Color fundus image · image size 2352x1568 · 45-degree field of view
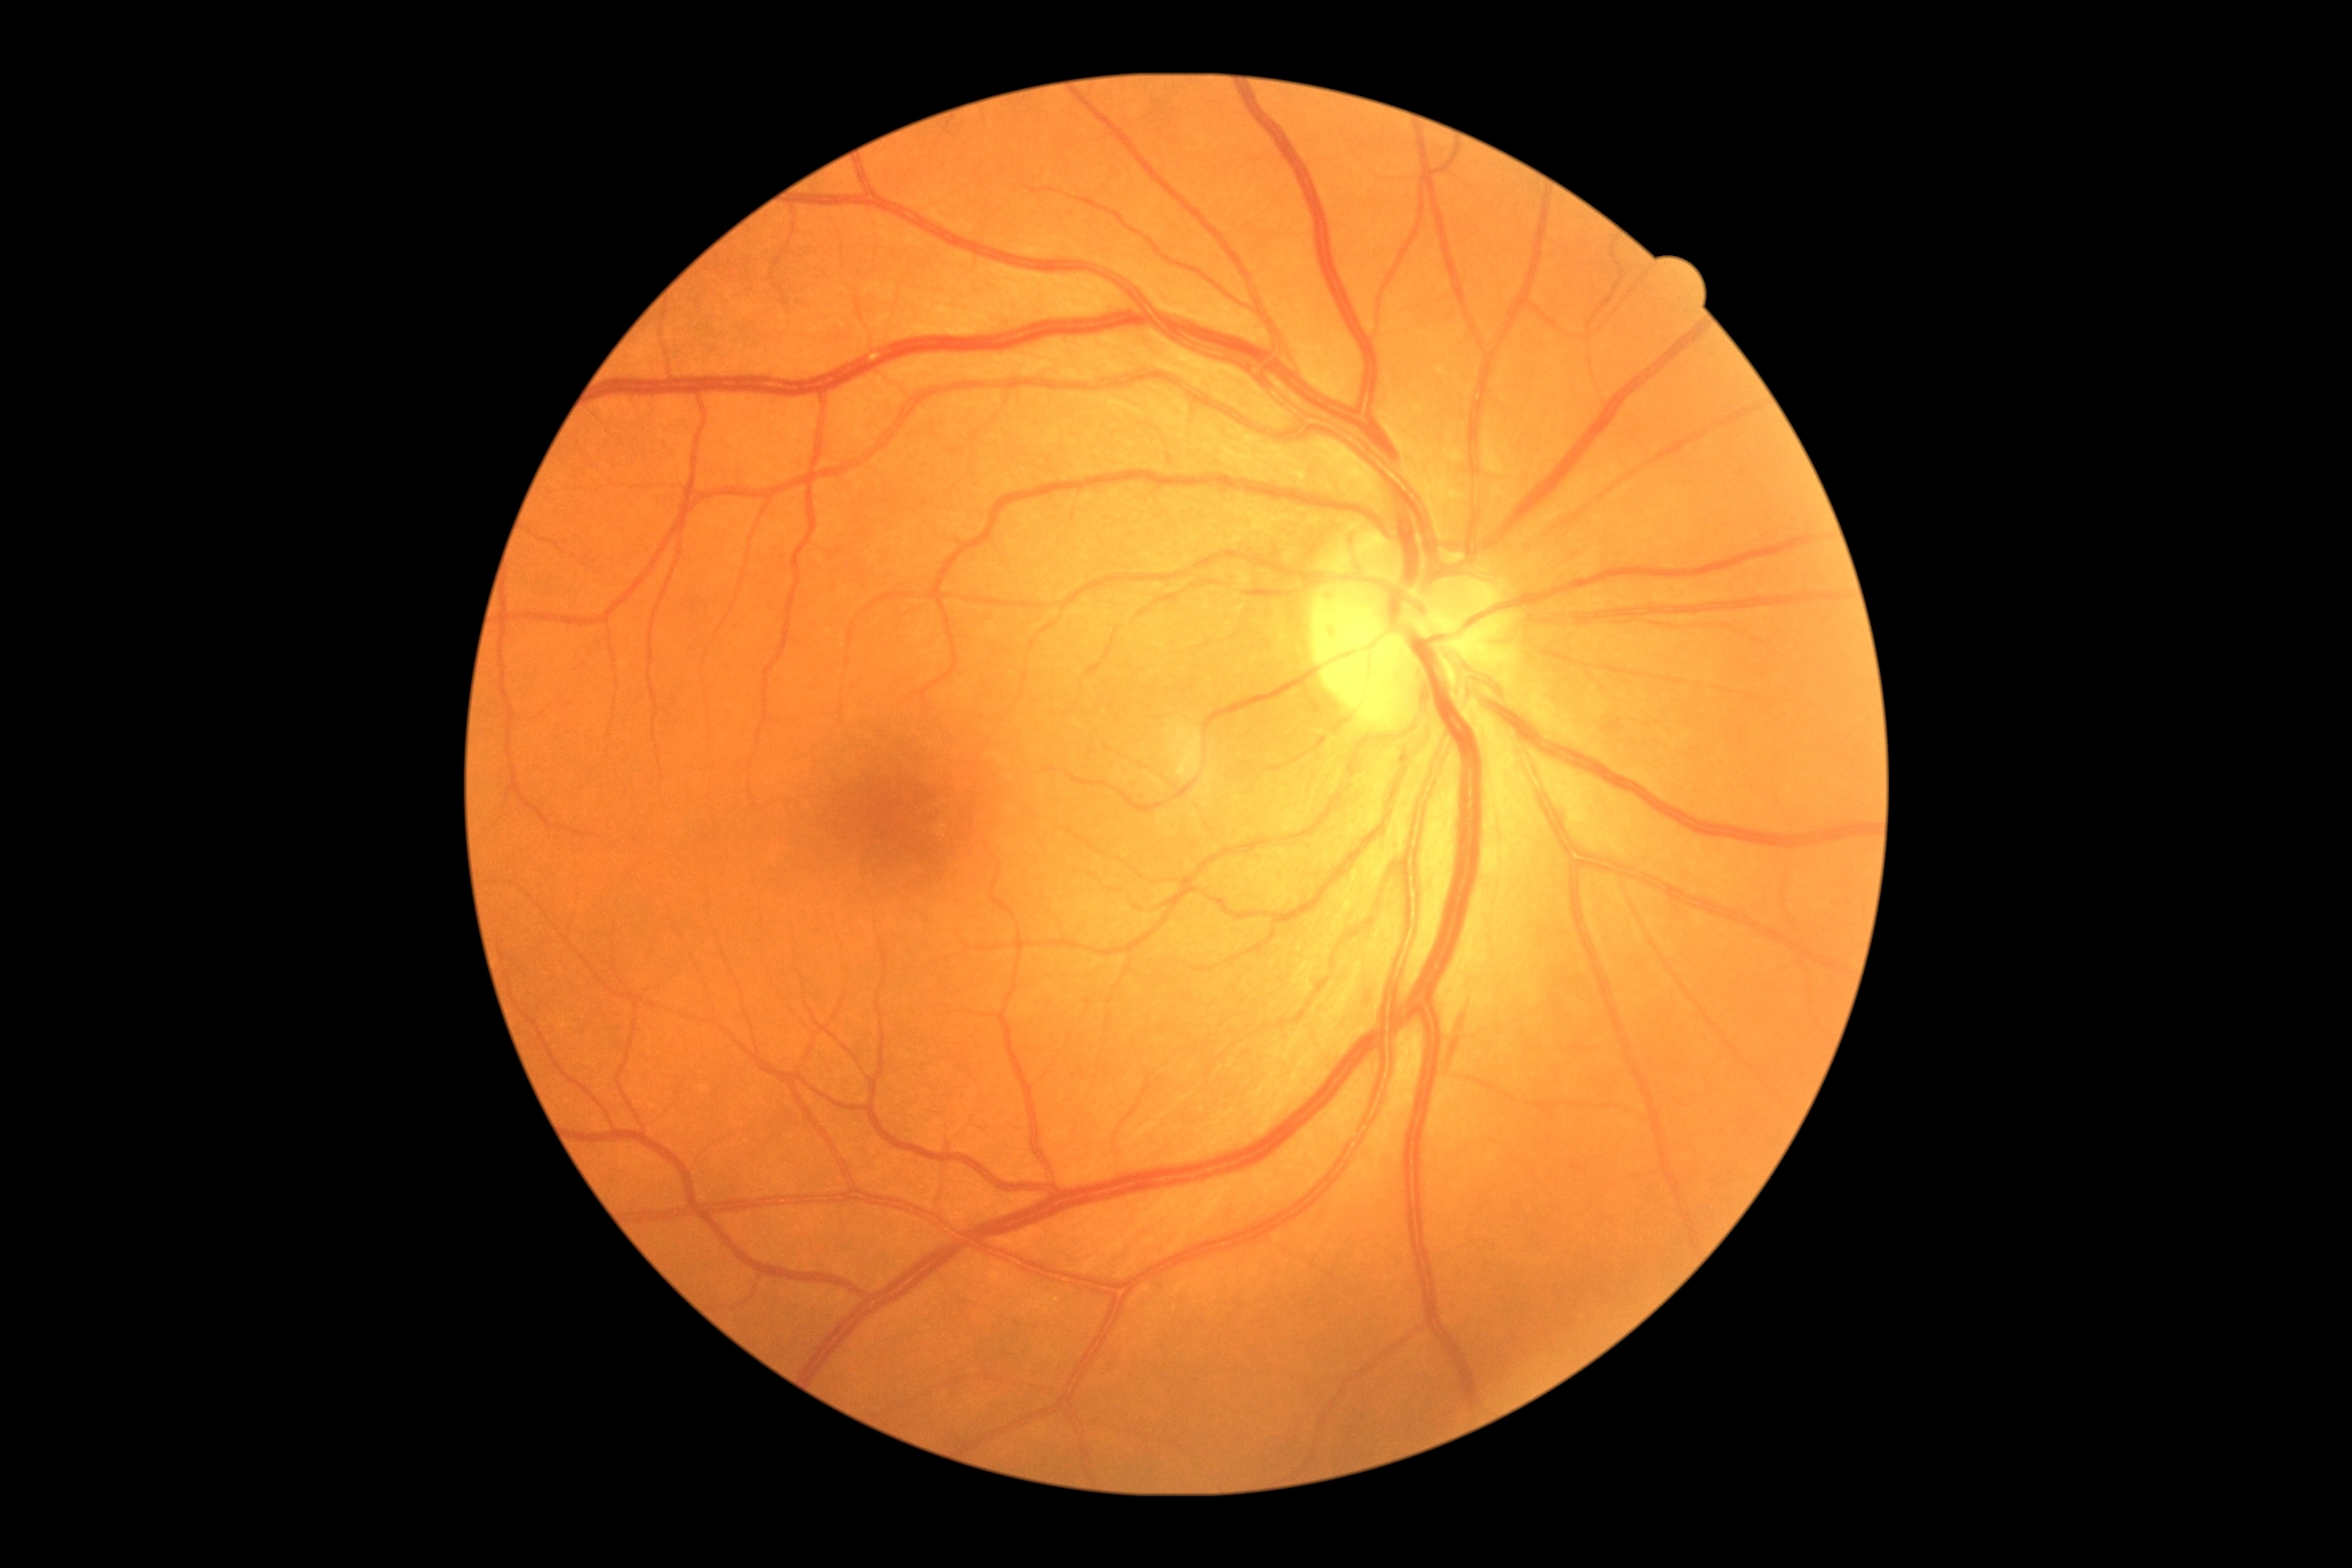

- DR stage: moderate non-proliferative diabetic retinopathy (grade 2)